FOV: 45 degrees; fundus photo:
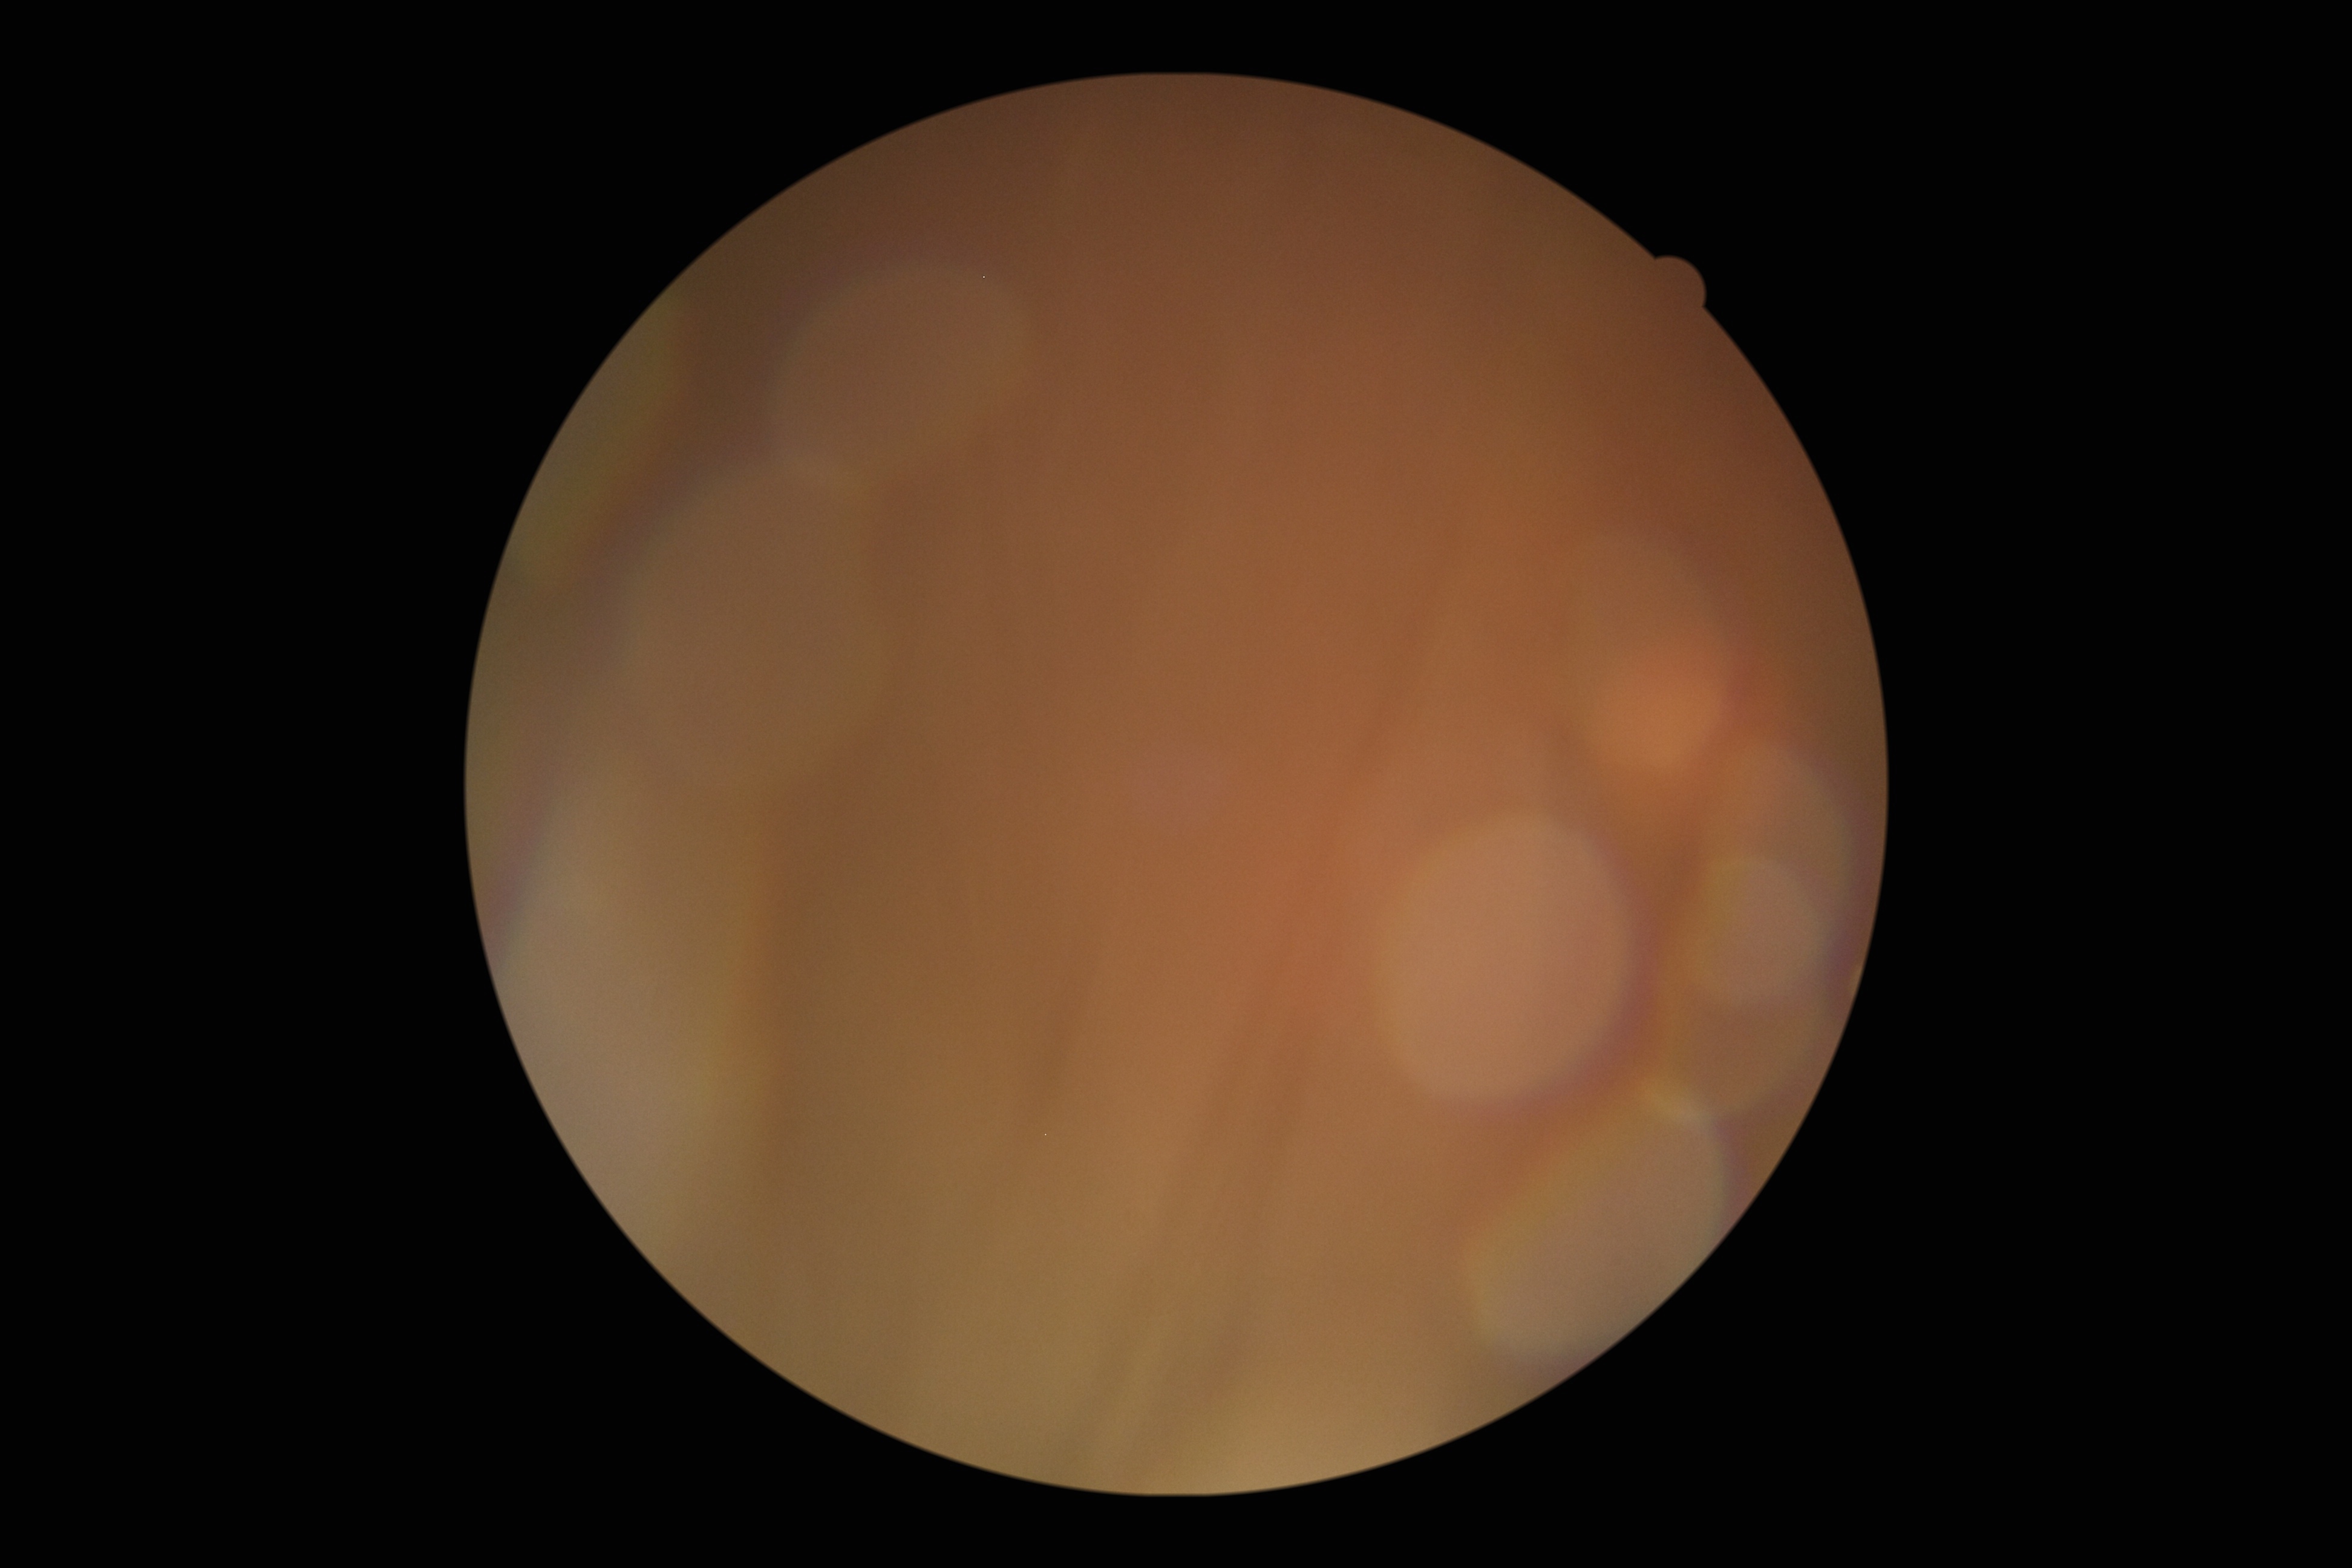
Diabetic retinopathy (DR) is ungradable due to poor image quality.